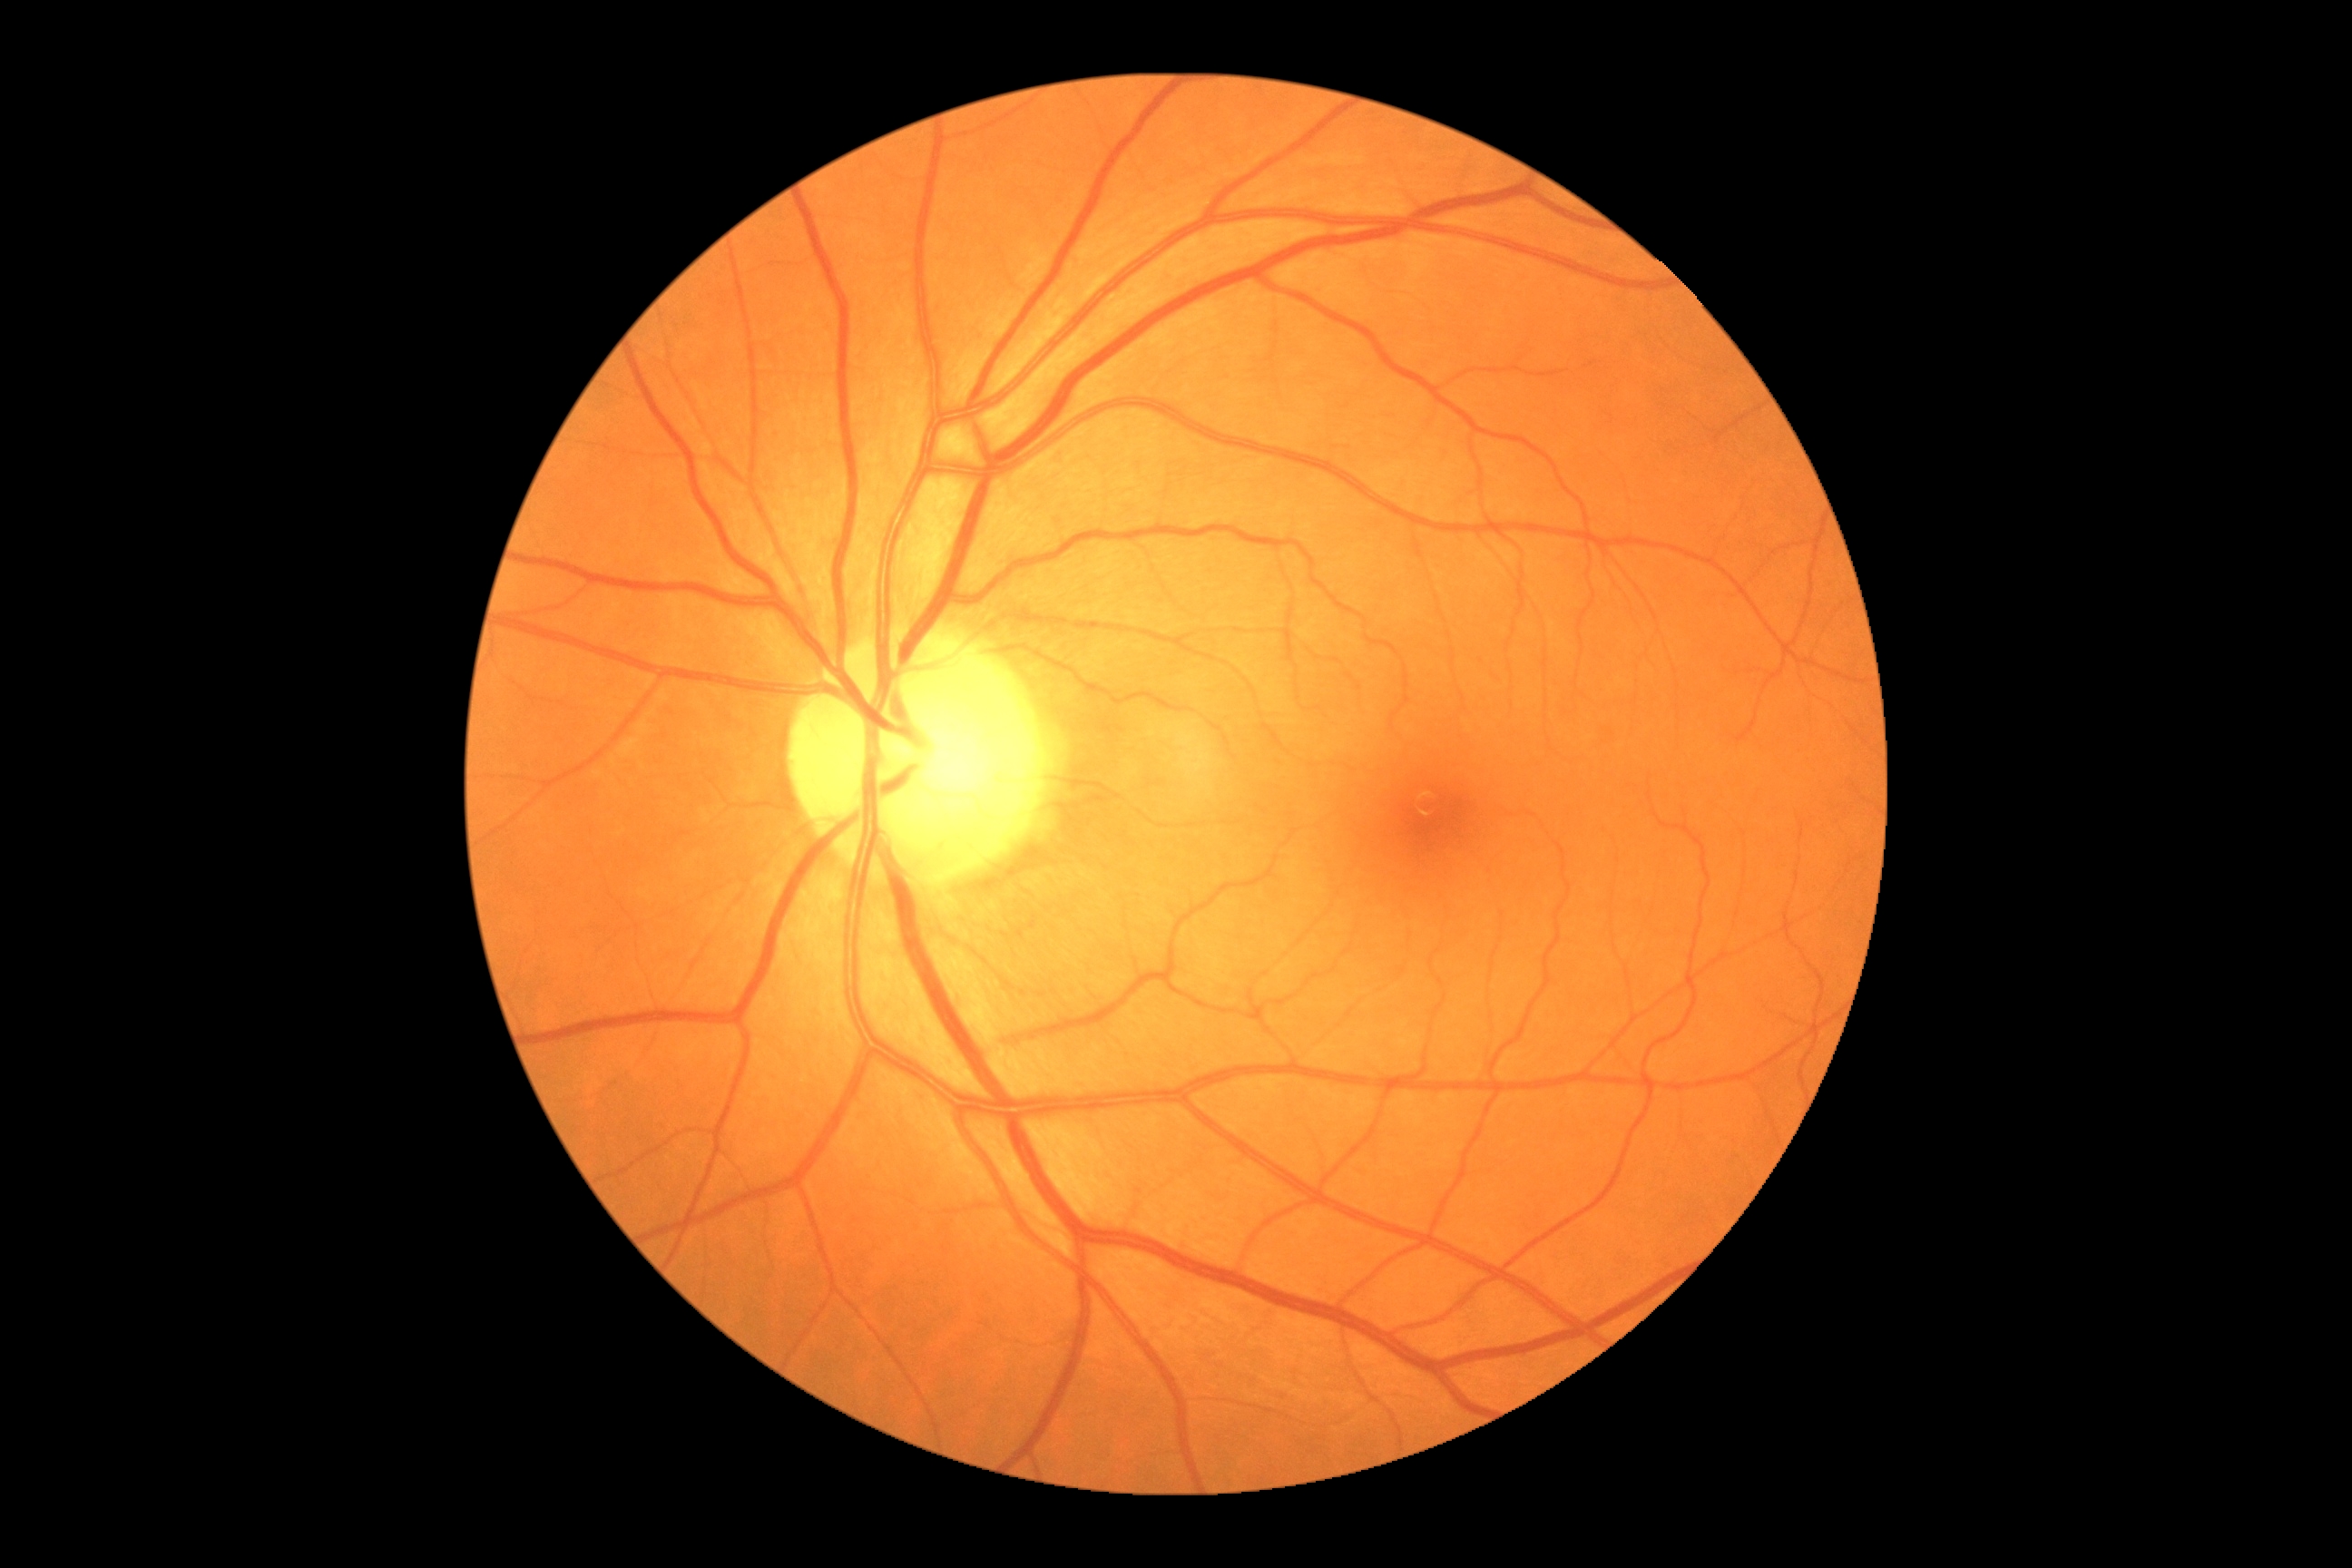

Diabetic retinopathy (DR) is 0/4.